Wide-field fundus photograph from neonatal ROP screening · captured with the Phoenix ICON (100° field of view) · 1240x1240:
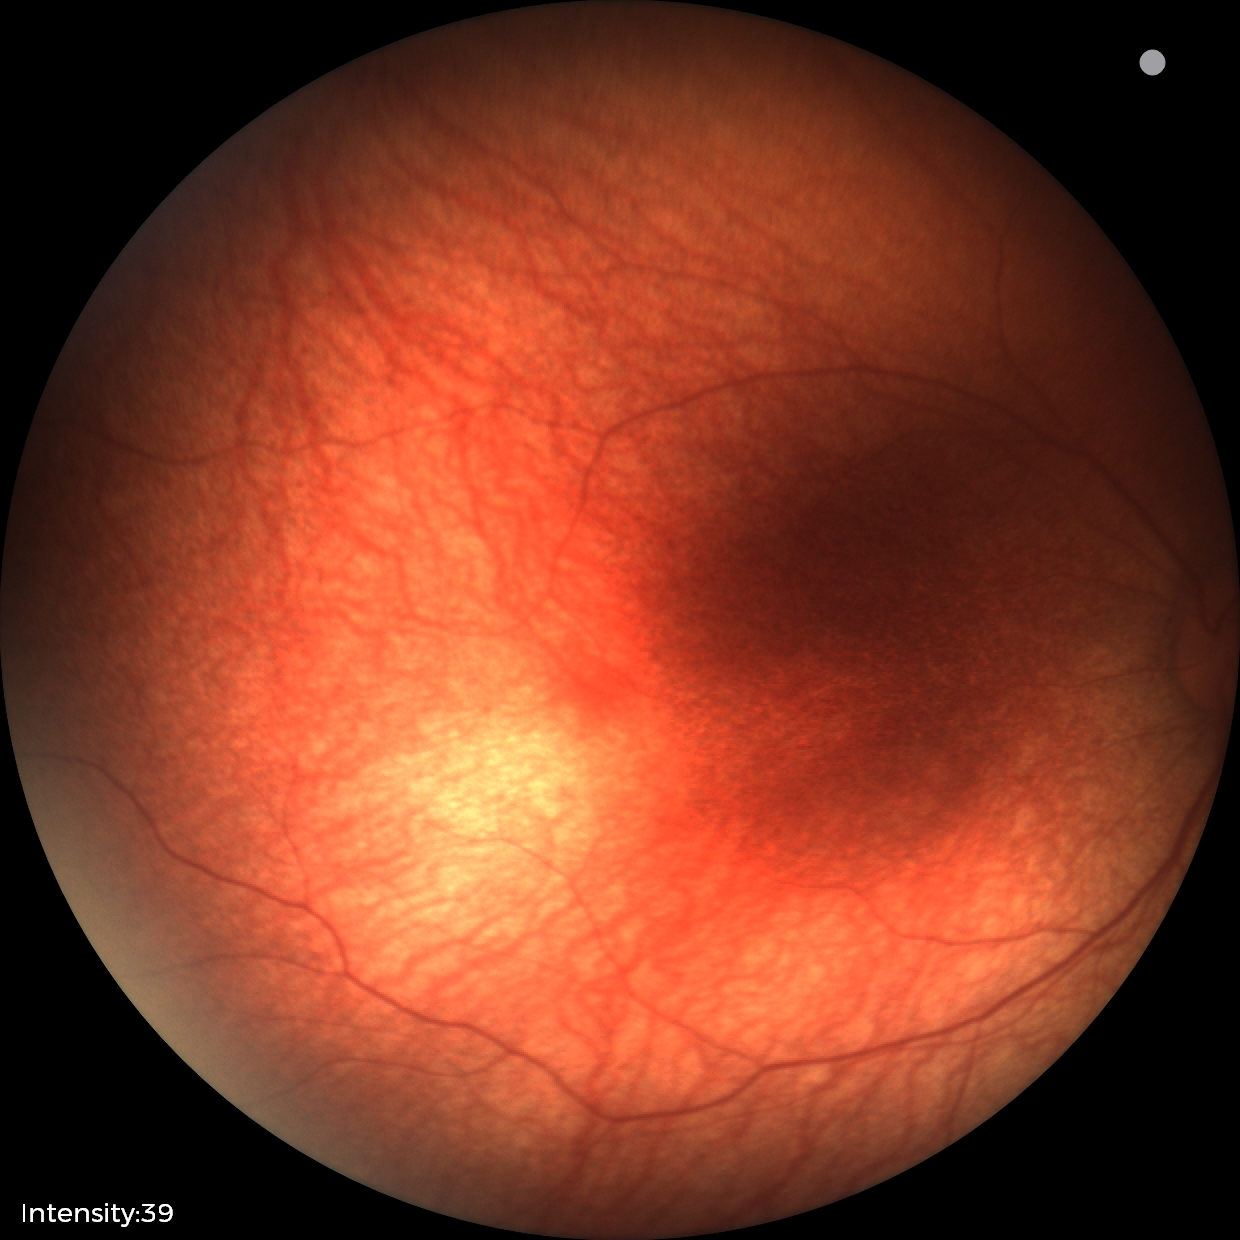
No retinal pathology identified on screening.